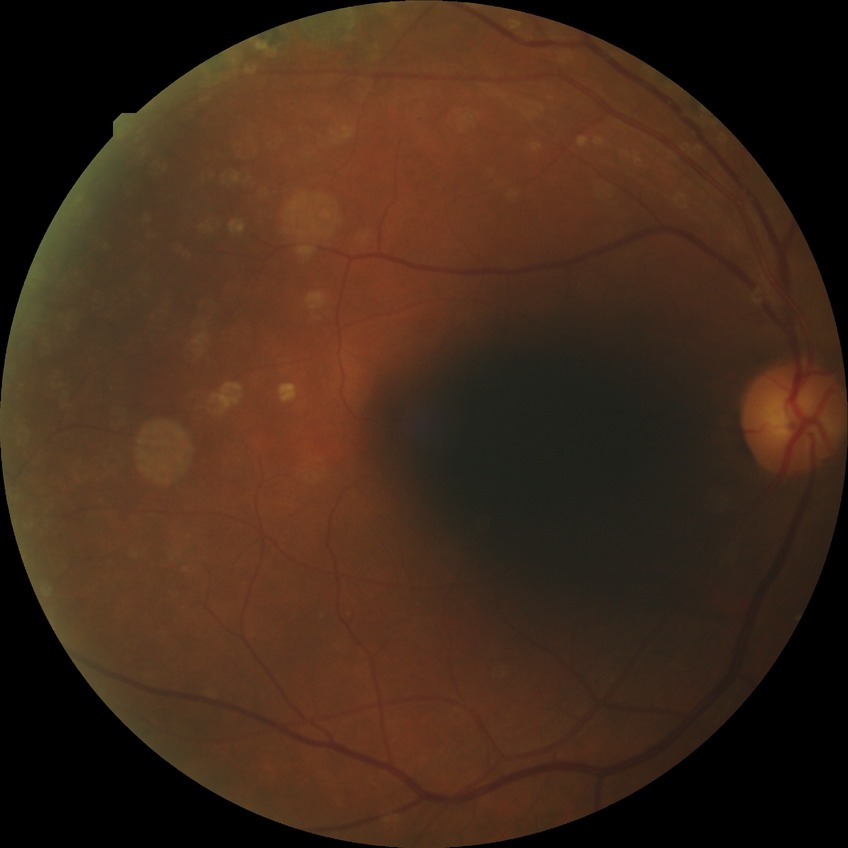
Diabetic retinopathy (DR): simple diabetic retinopathy (SDR). The retinopathy is classified as non-proliferative diabetic retinopathy.